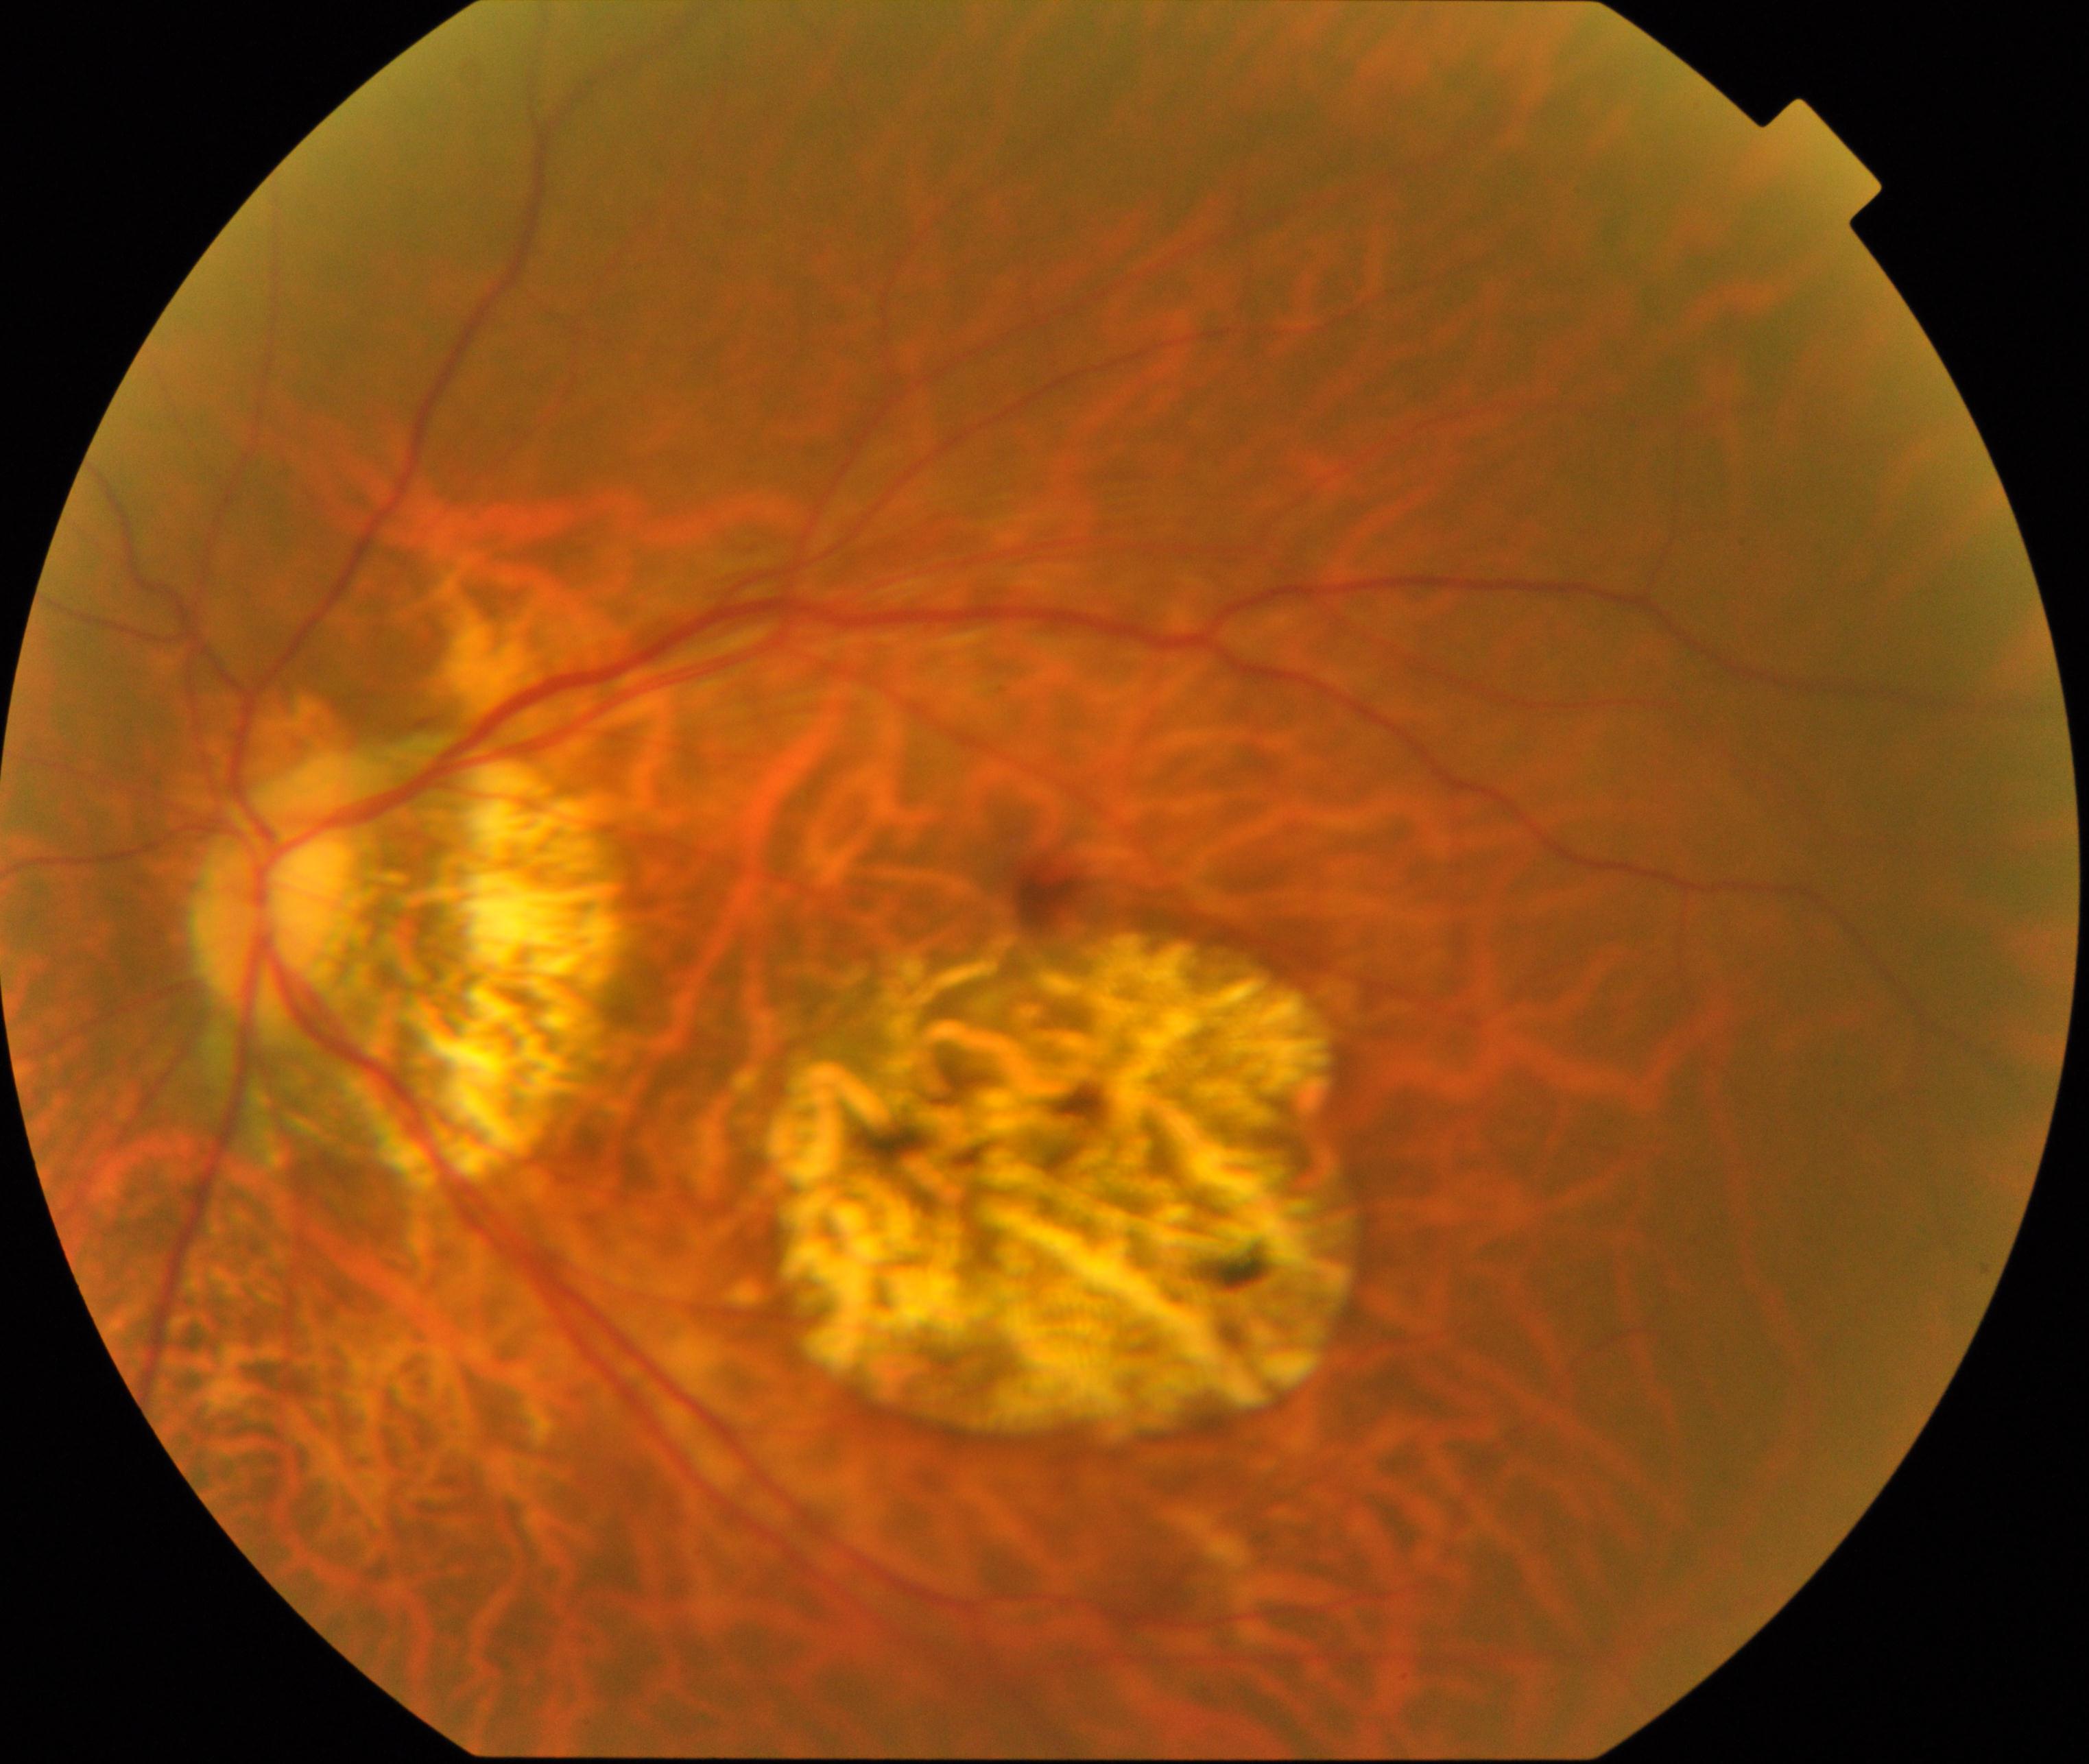
Classification: pathological myopia.